Graded on the modified Davis scale — 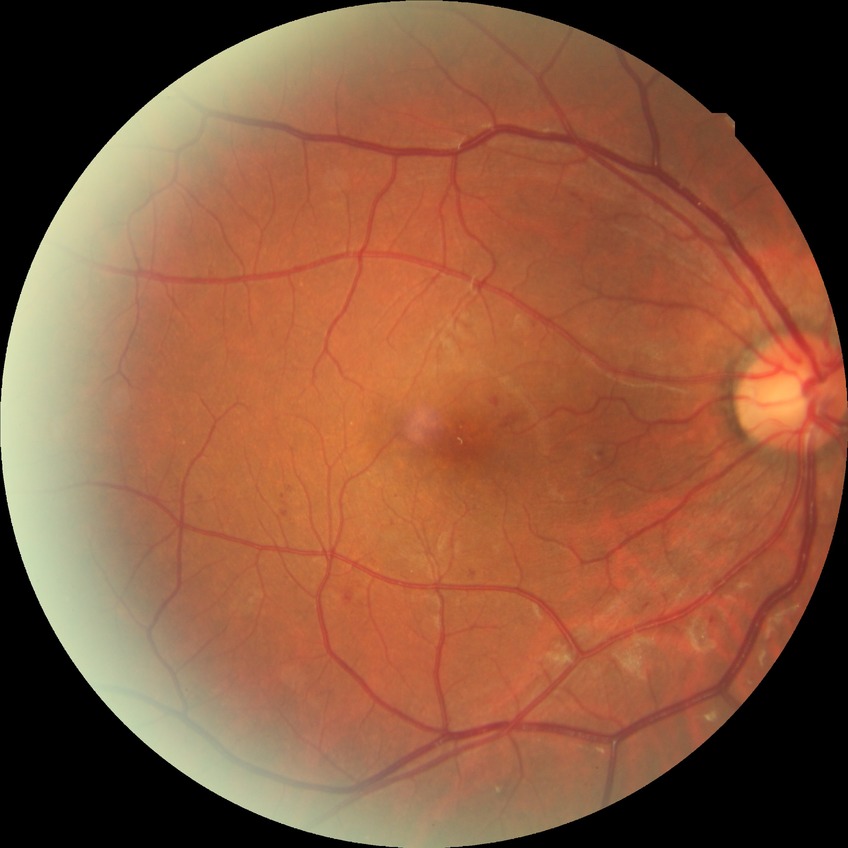

diabetic retinopathy (DR) = simple diabetic retinopathy (SDR).